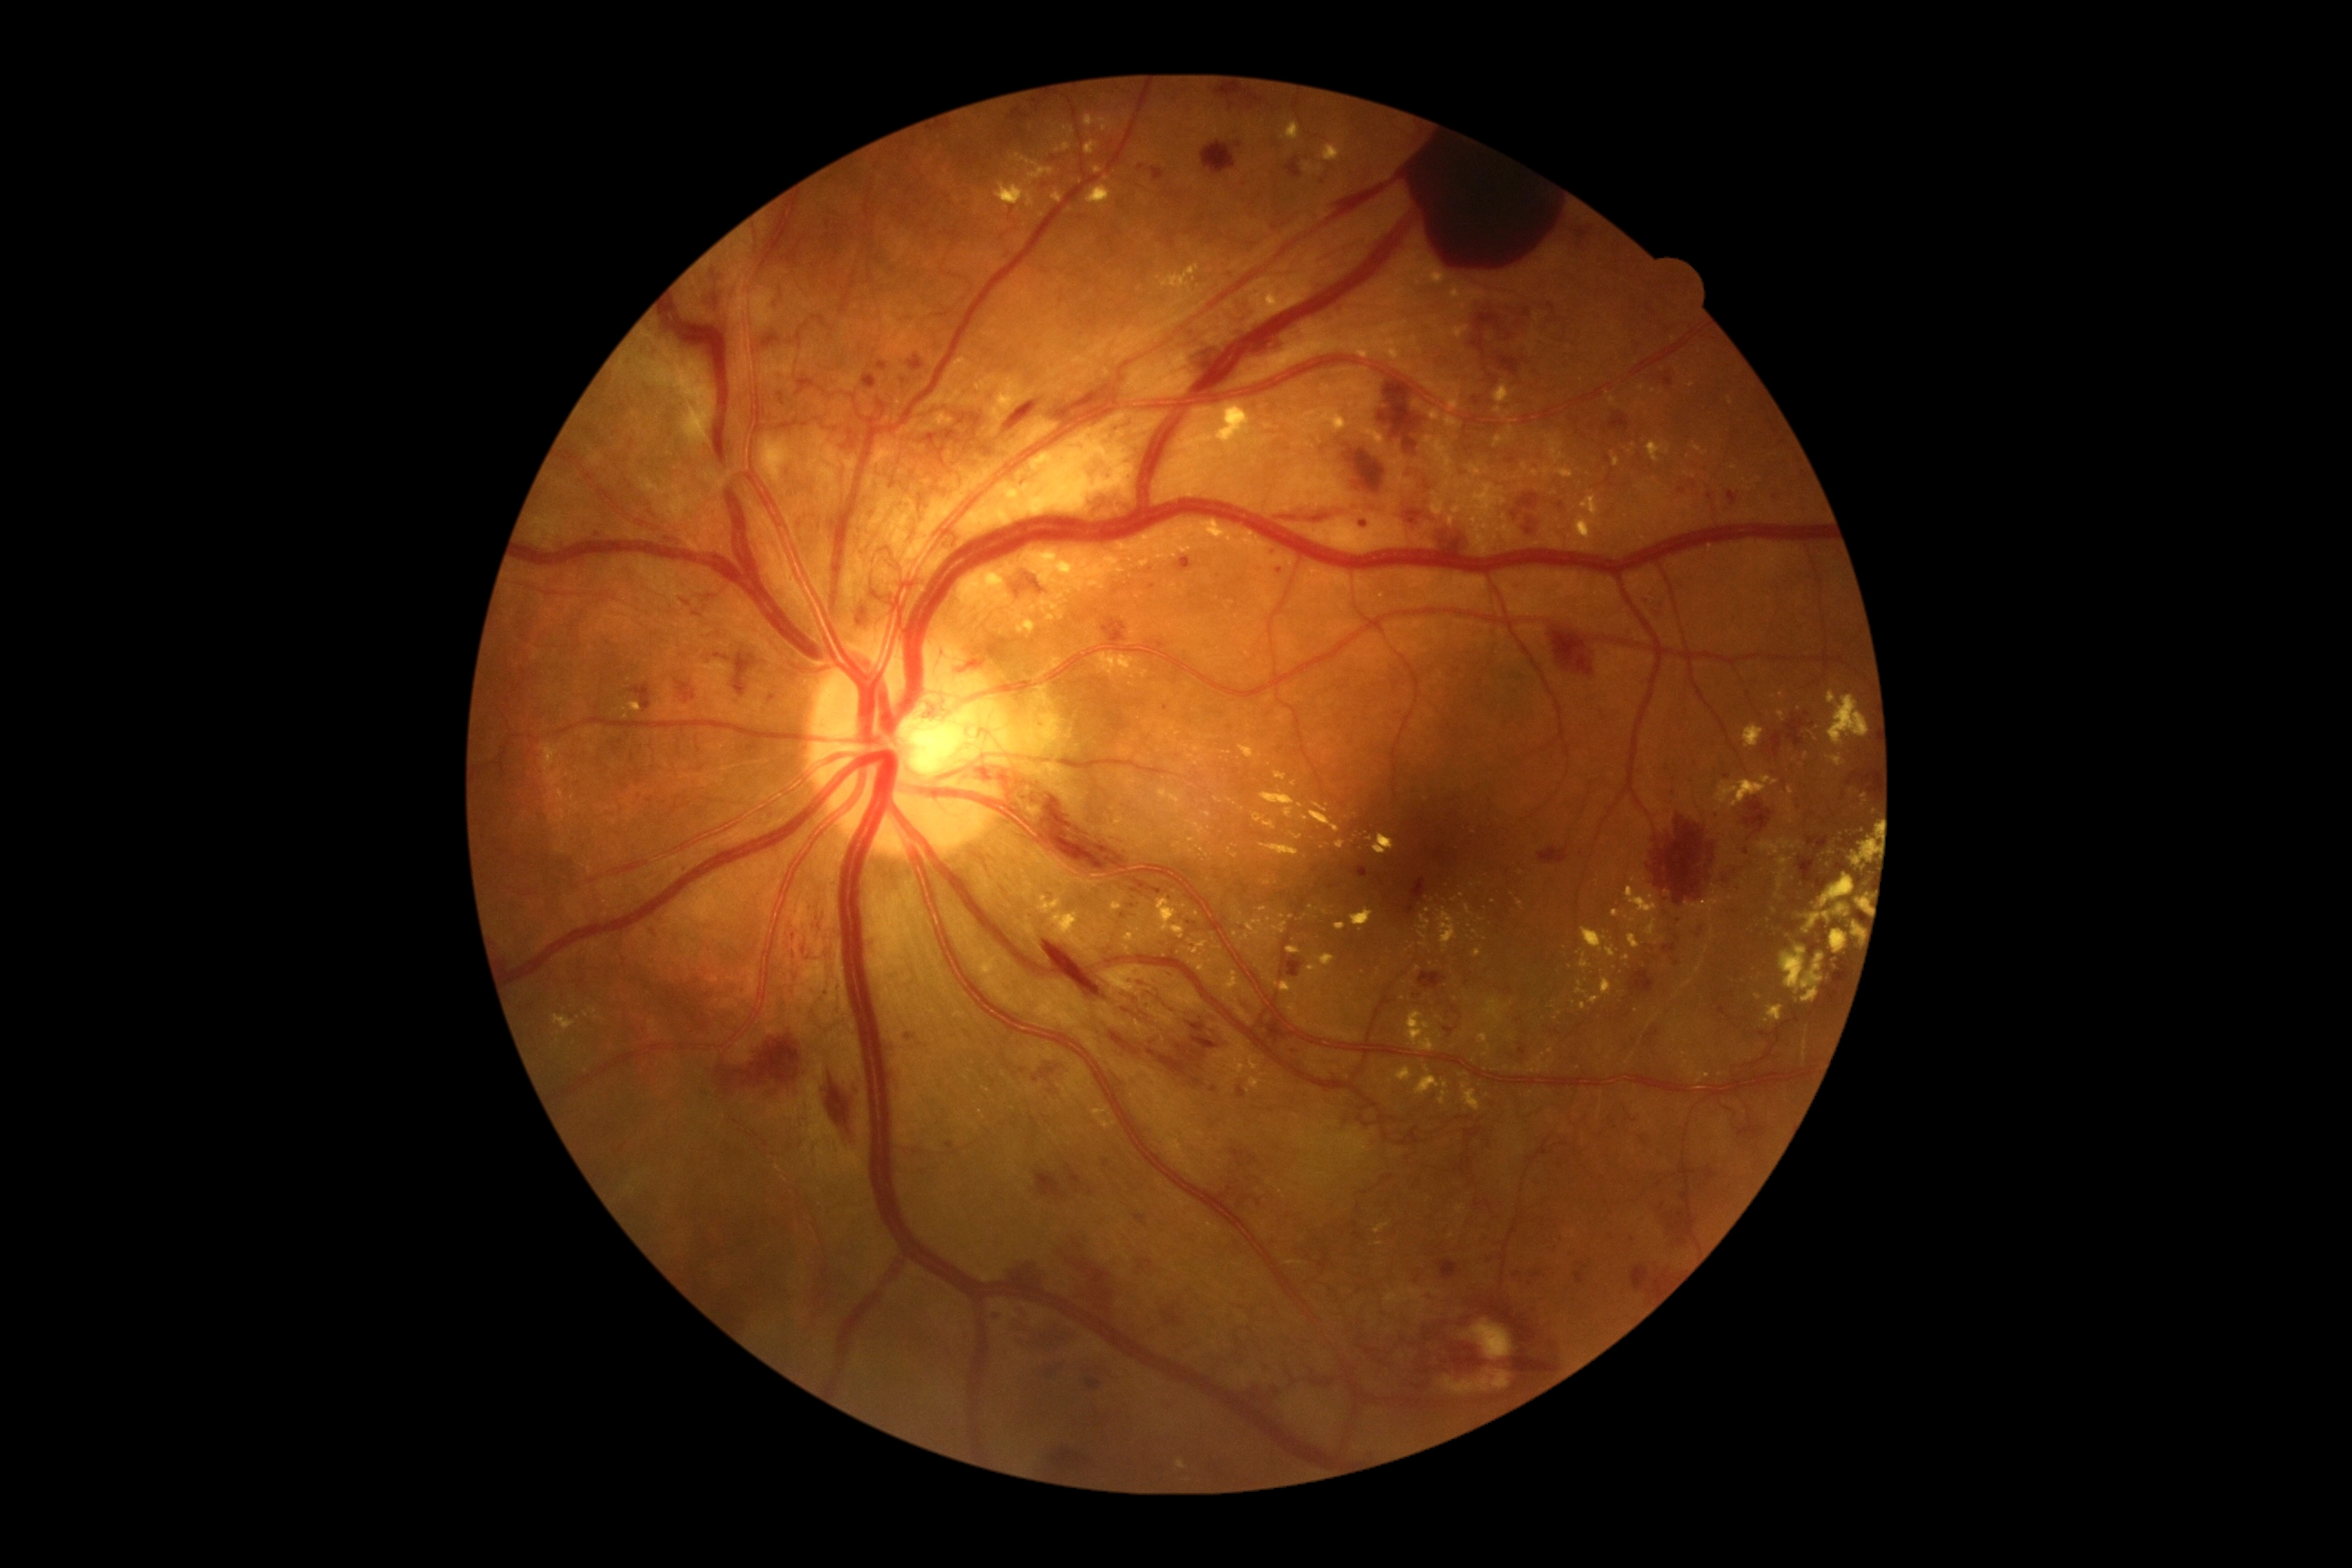 Diabetic retinopathy (DR) is 4
Representative lesions:
* hemorrhages (HEs) (partial): bbox(647, 926, 660, 945), bbox(1286, 157, 1304, 181), bbox(1004, 567, 1046, 602), bbox(1418, 972, 1447, 990), bbox(1035, 1171, 1064, 1199), bbox(1676, 917, 1685, 925), bbox(1645, 808, 1720, 906), bbox(1268, 547, 1279, 556), bbox(1578, 1262, 1589, 1269), bbox(906, 1030, 919, 1043), bbox(1411, 990, 1424, 1001), bbox(1834, 972, 1847, 994), bbox(1360, 522, 1369, 527), bbox(1721, 861, 1756, 892), bbox(1623, 1262, 1674, 1302)
* Small HEs near (x=669, y=540), (x=1857, y=802), (x=1610, y=1236)
* hard exudates (EXs) (partial): bbox(1126, 781, 1135, 798), bbox(1084, 142, 1099, 155), bbox(1228, 799, 1237, 805), bbox(1104, 816, 1155, 848), bbox(1407, 1012, 1435, 1052), bbox(1475, 948, 1482, 957), bbox(1088, 186, 1112, 210), bbox(1803, 874, 1856, 936), bbox(1289, 832, 1302, 841), bbox(1308, 965, 1320, 972), bbox(1124, 925, 1148, 945), bbox(1269, 979, 1293, 994)
* Small EXs near (x=1775, y=911), (x=1190, y=758), (x=1420, y=351), (x=1197, y=765), (x=1121, y=776), (x=1792, y=821), (x=1267, y=884)